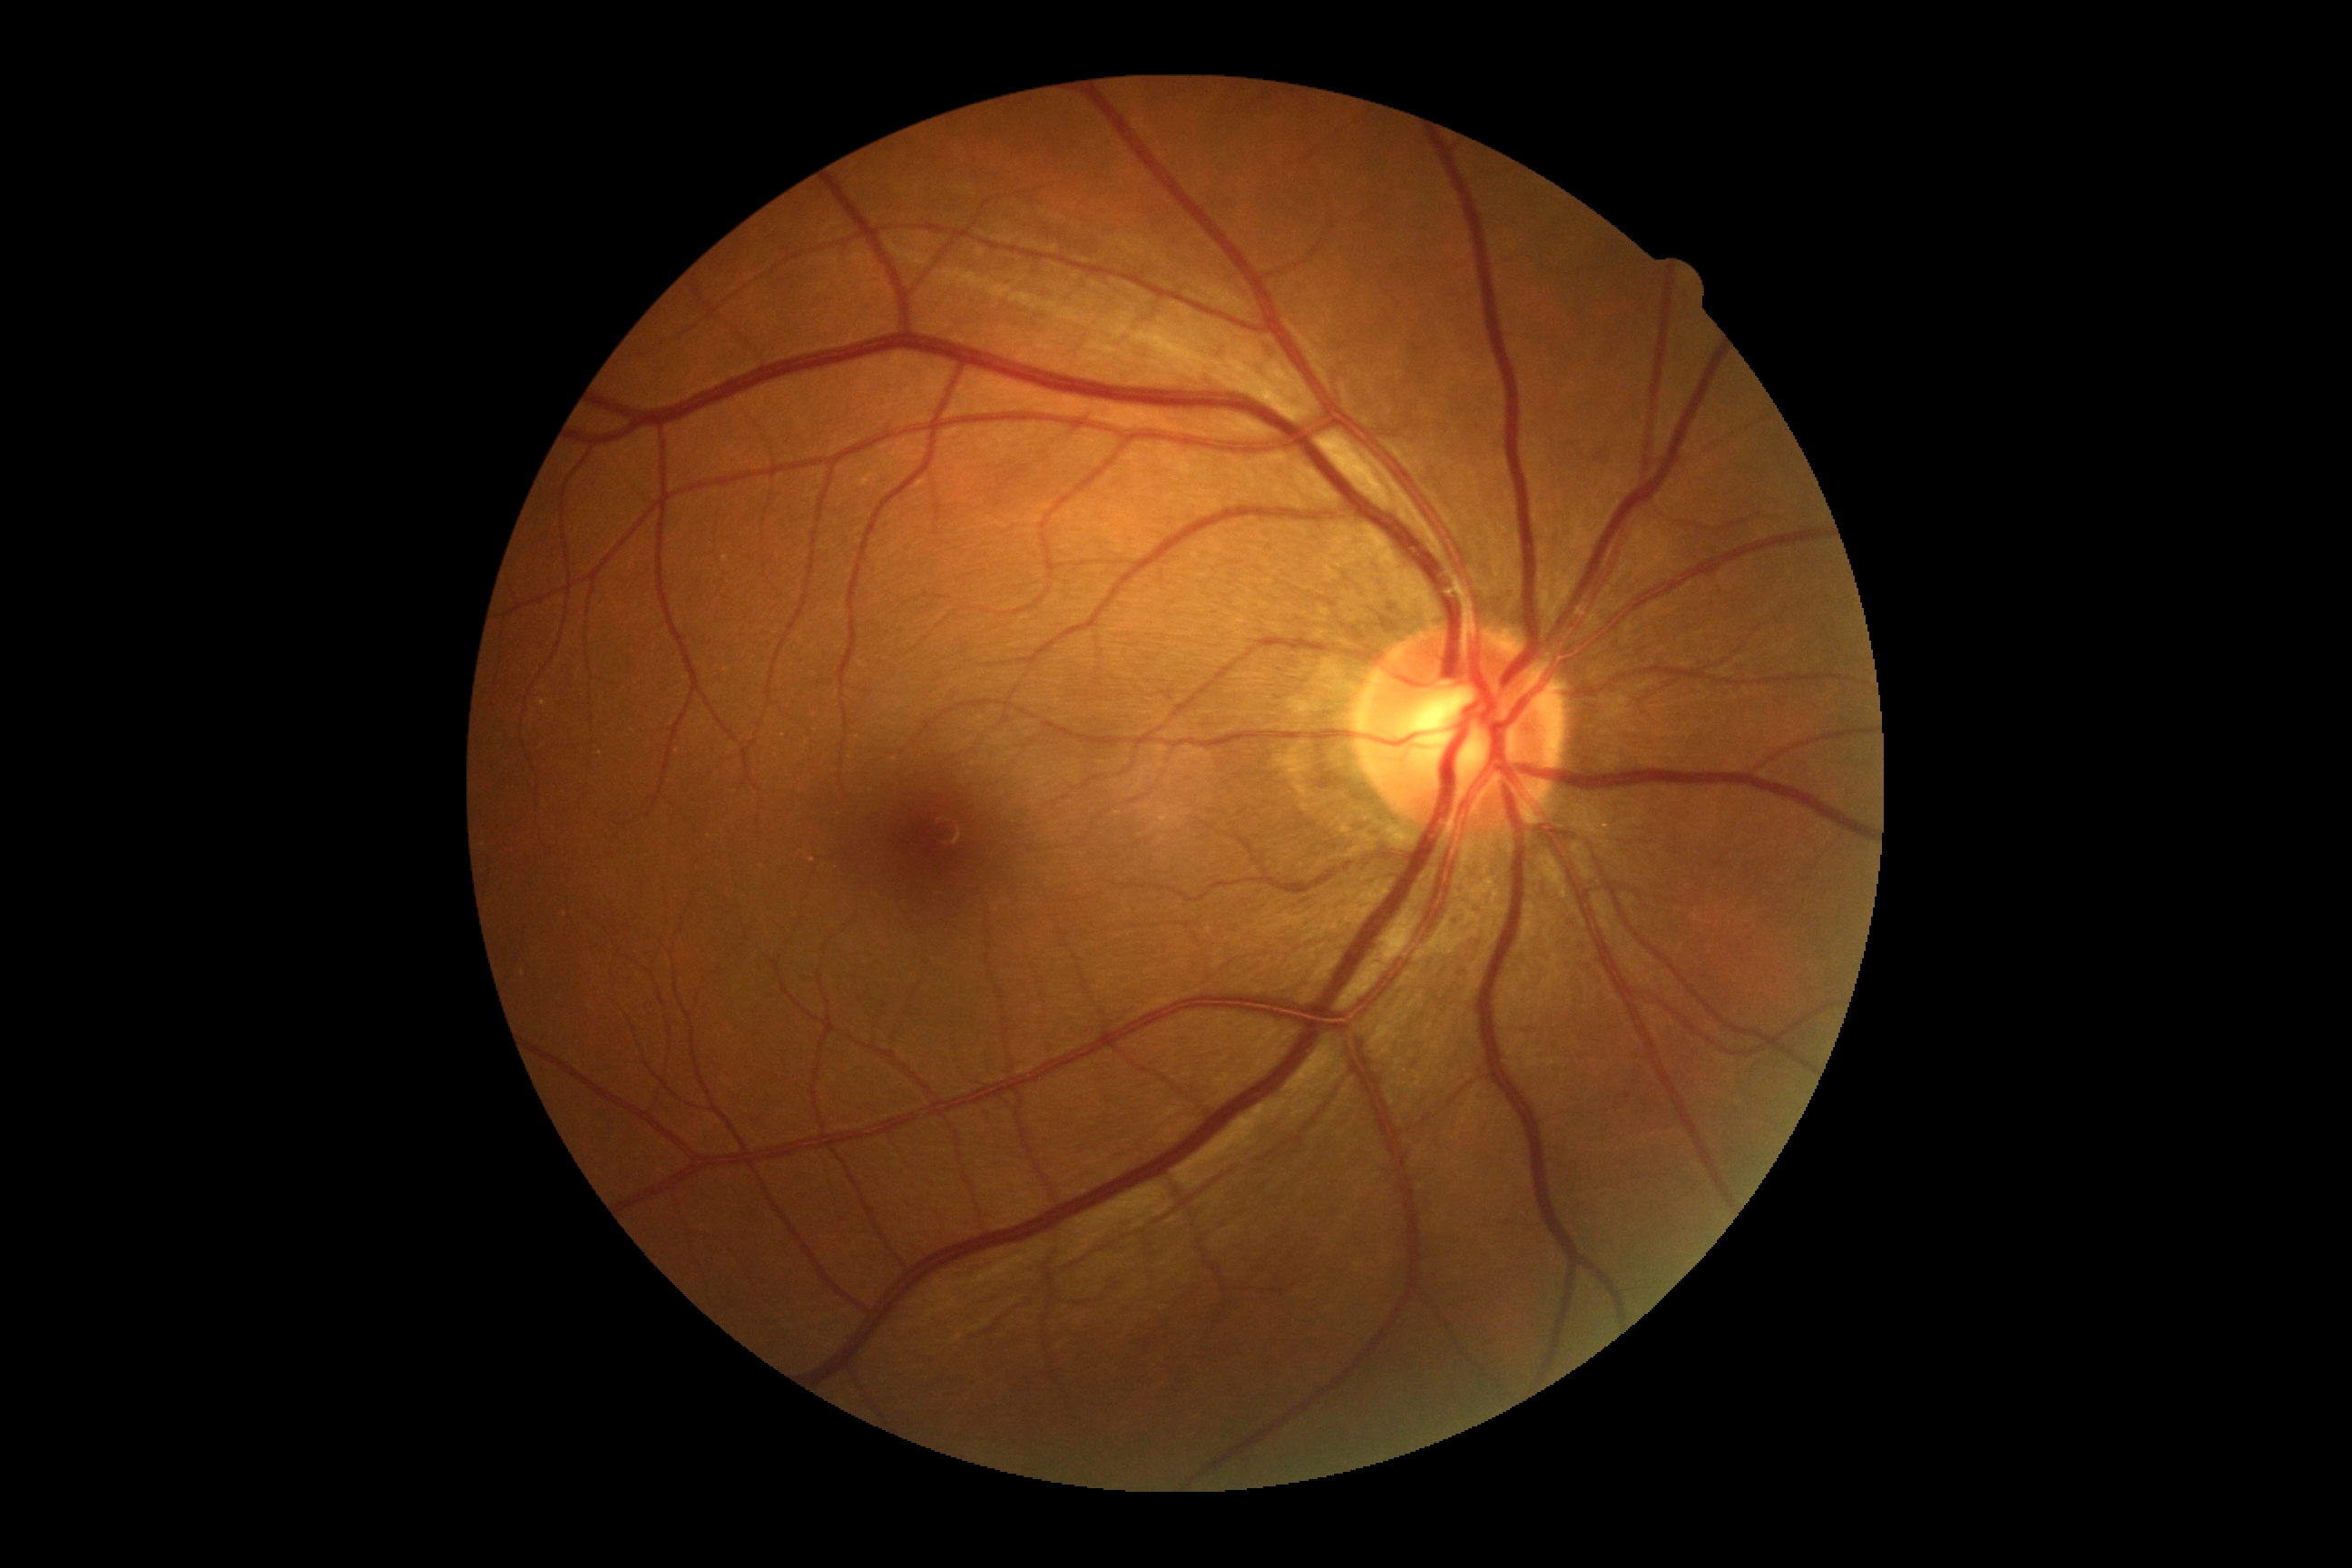

No apparent diabetic retinopathy. Diabetic retinopathy (DR): 0/4.